Color fundus image.
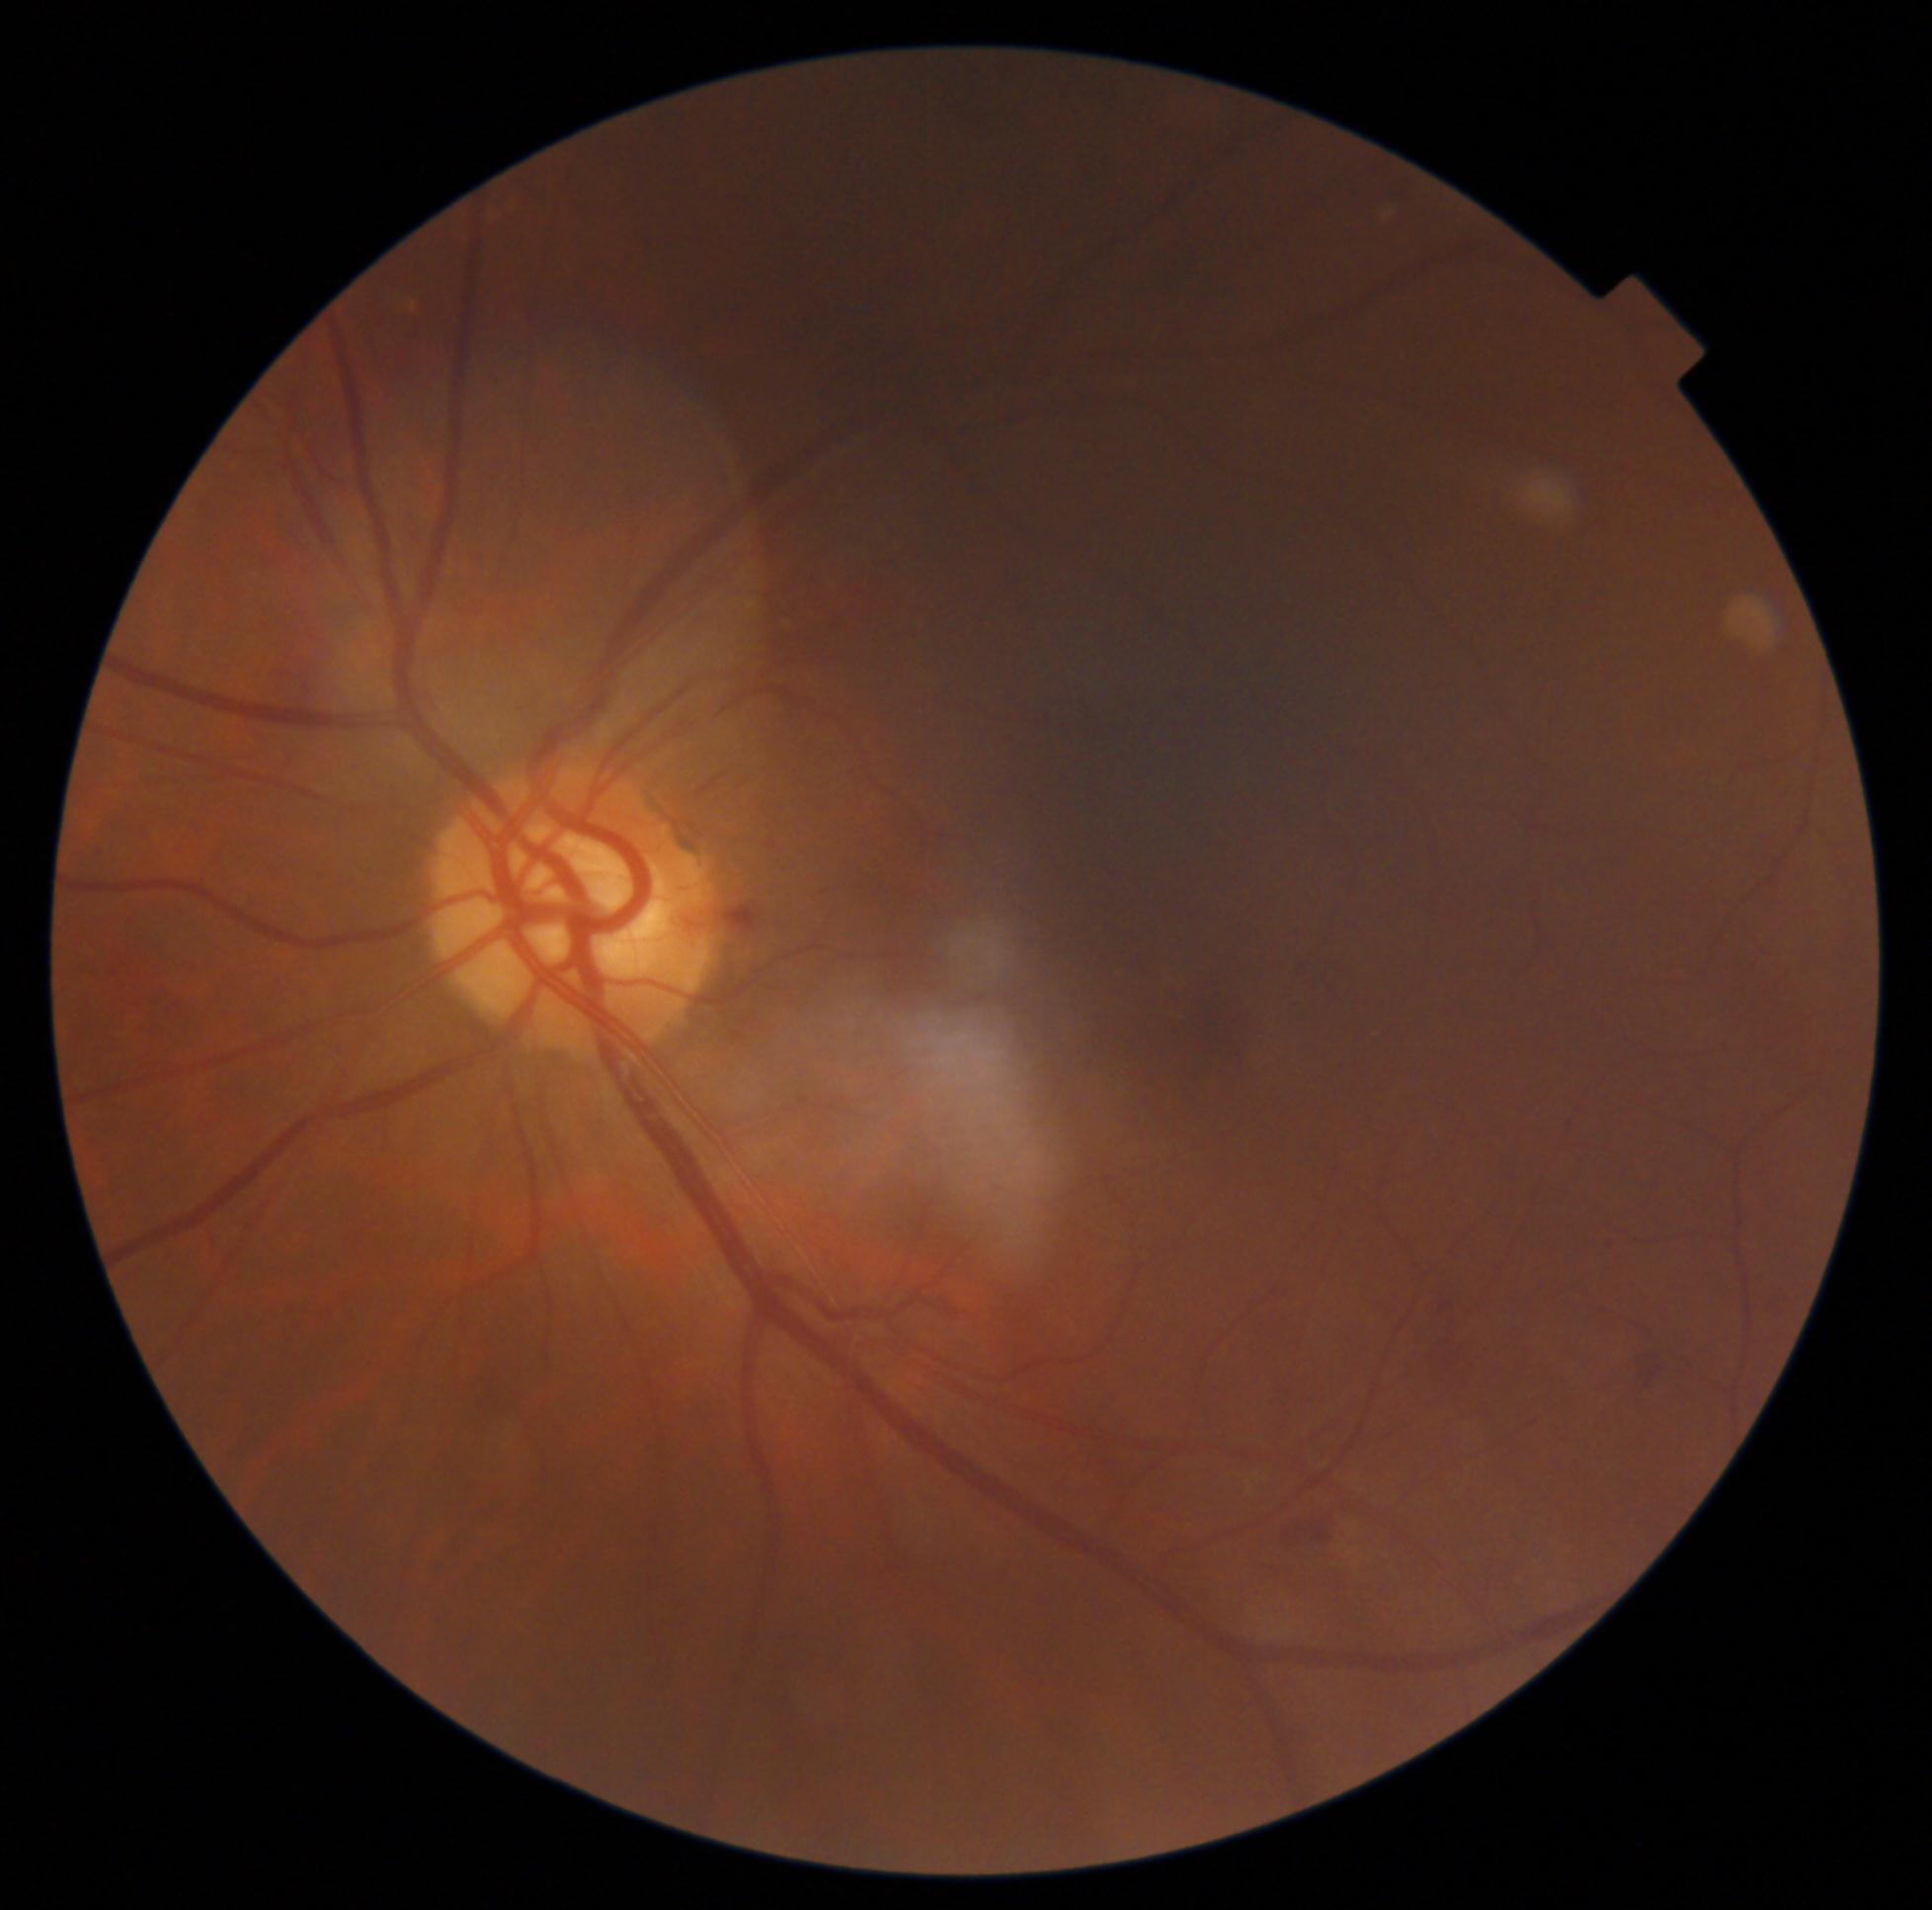 Retinopathy: grade 2 (moderate NPDR).